Camera: NIDEK AFC-230; modified Davis classification:
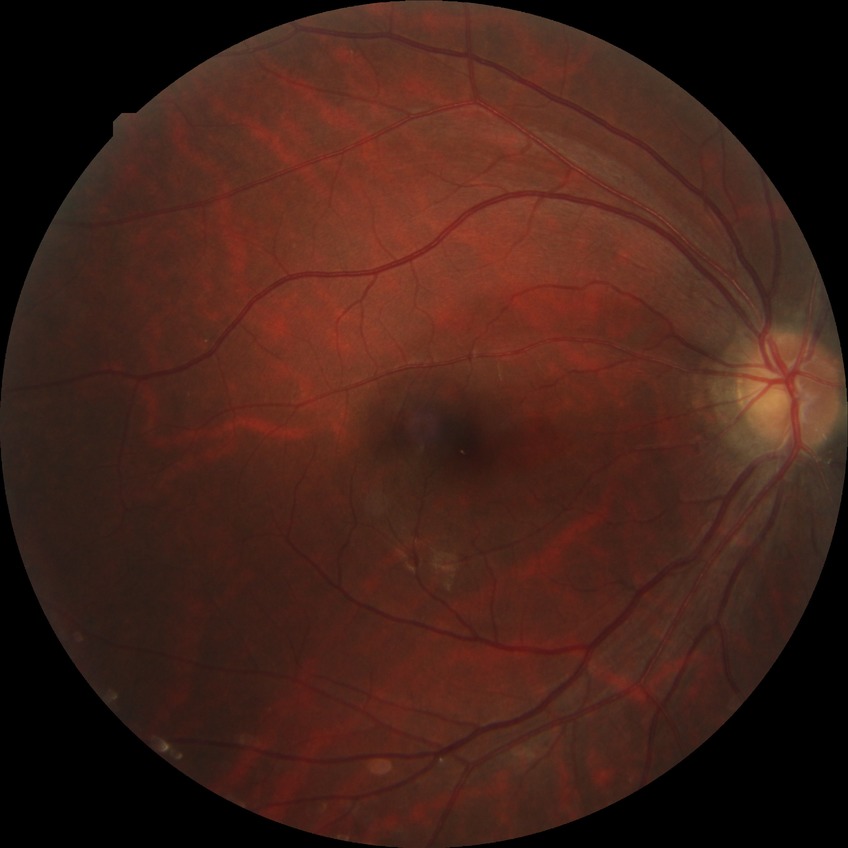
davis_grade: NDR